Nonmydriatic; color fundus image:
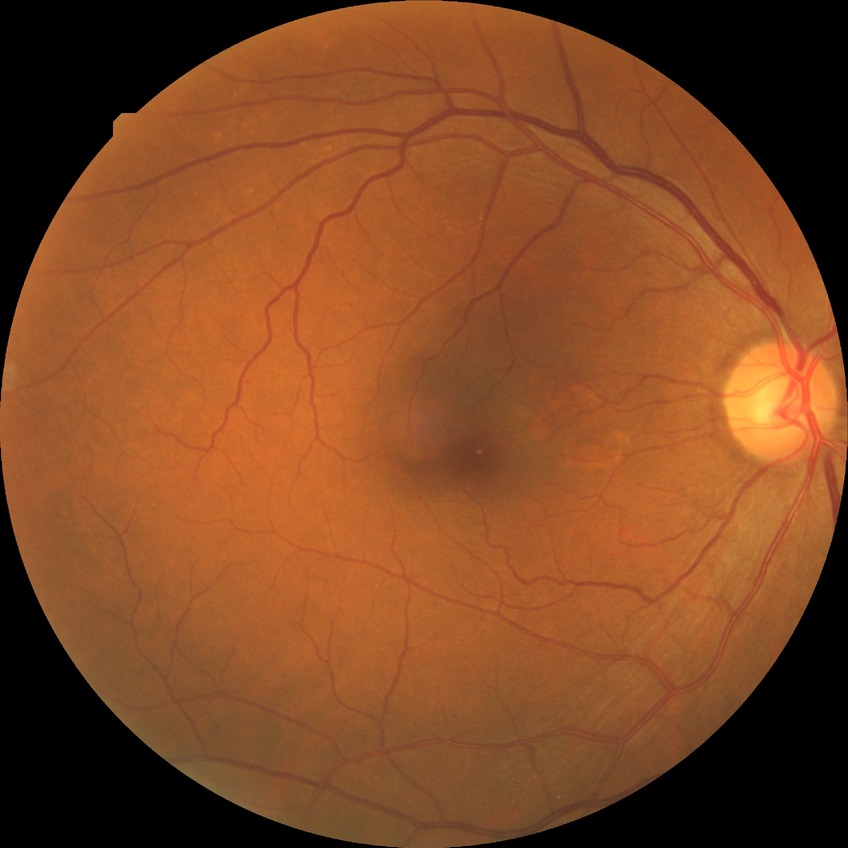 retinopathy stage: no diabetic retinopathy.